Wide-field fundus photograph of an infant
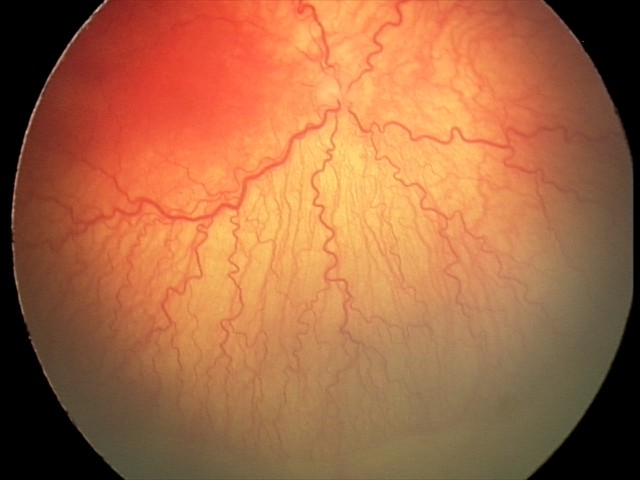

Impression: aggressive retinopathy of prematurity (A-ROP) — rapidly progressive severe ROP with prominent plus disease, often without classic stage progression, plus disease: present — abnormal dilation and tortuosity of the posterior pole retinal vessels.